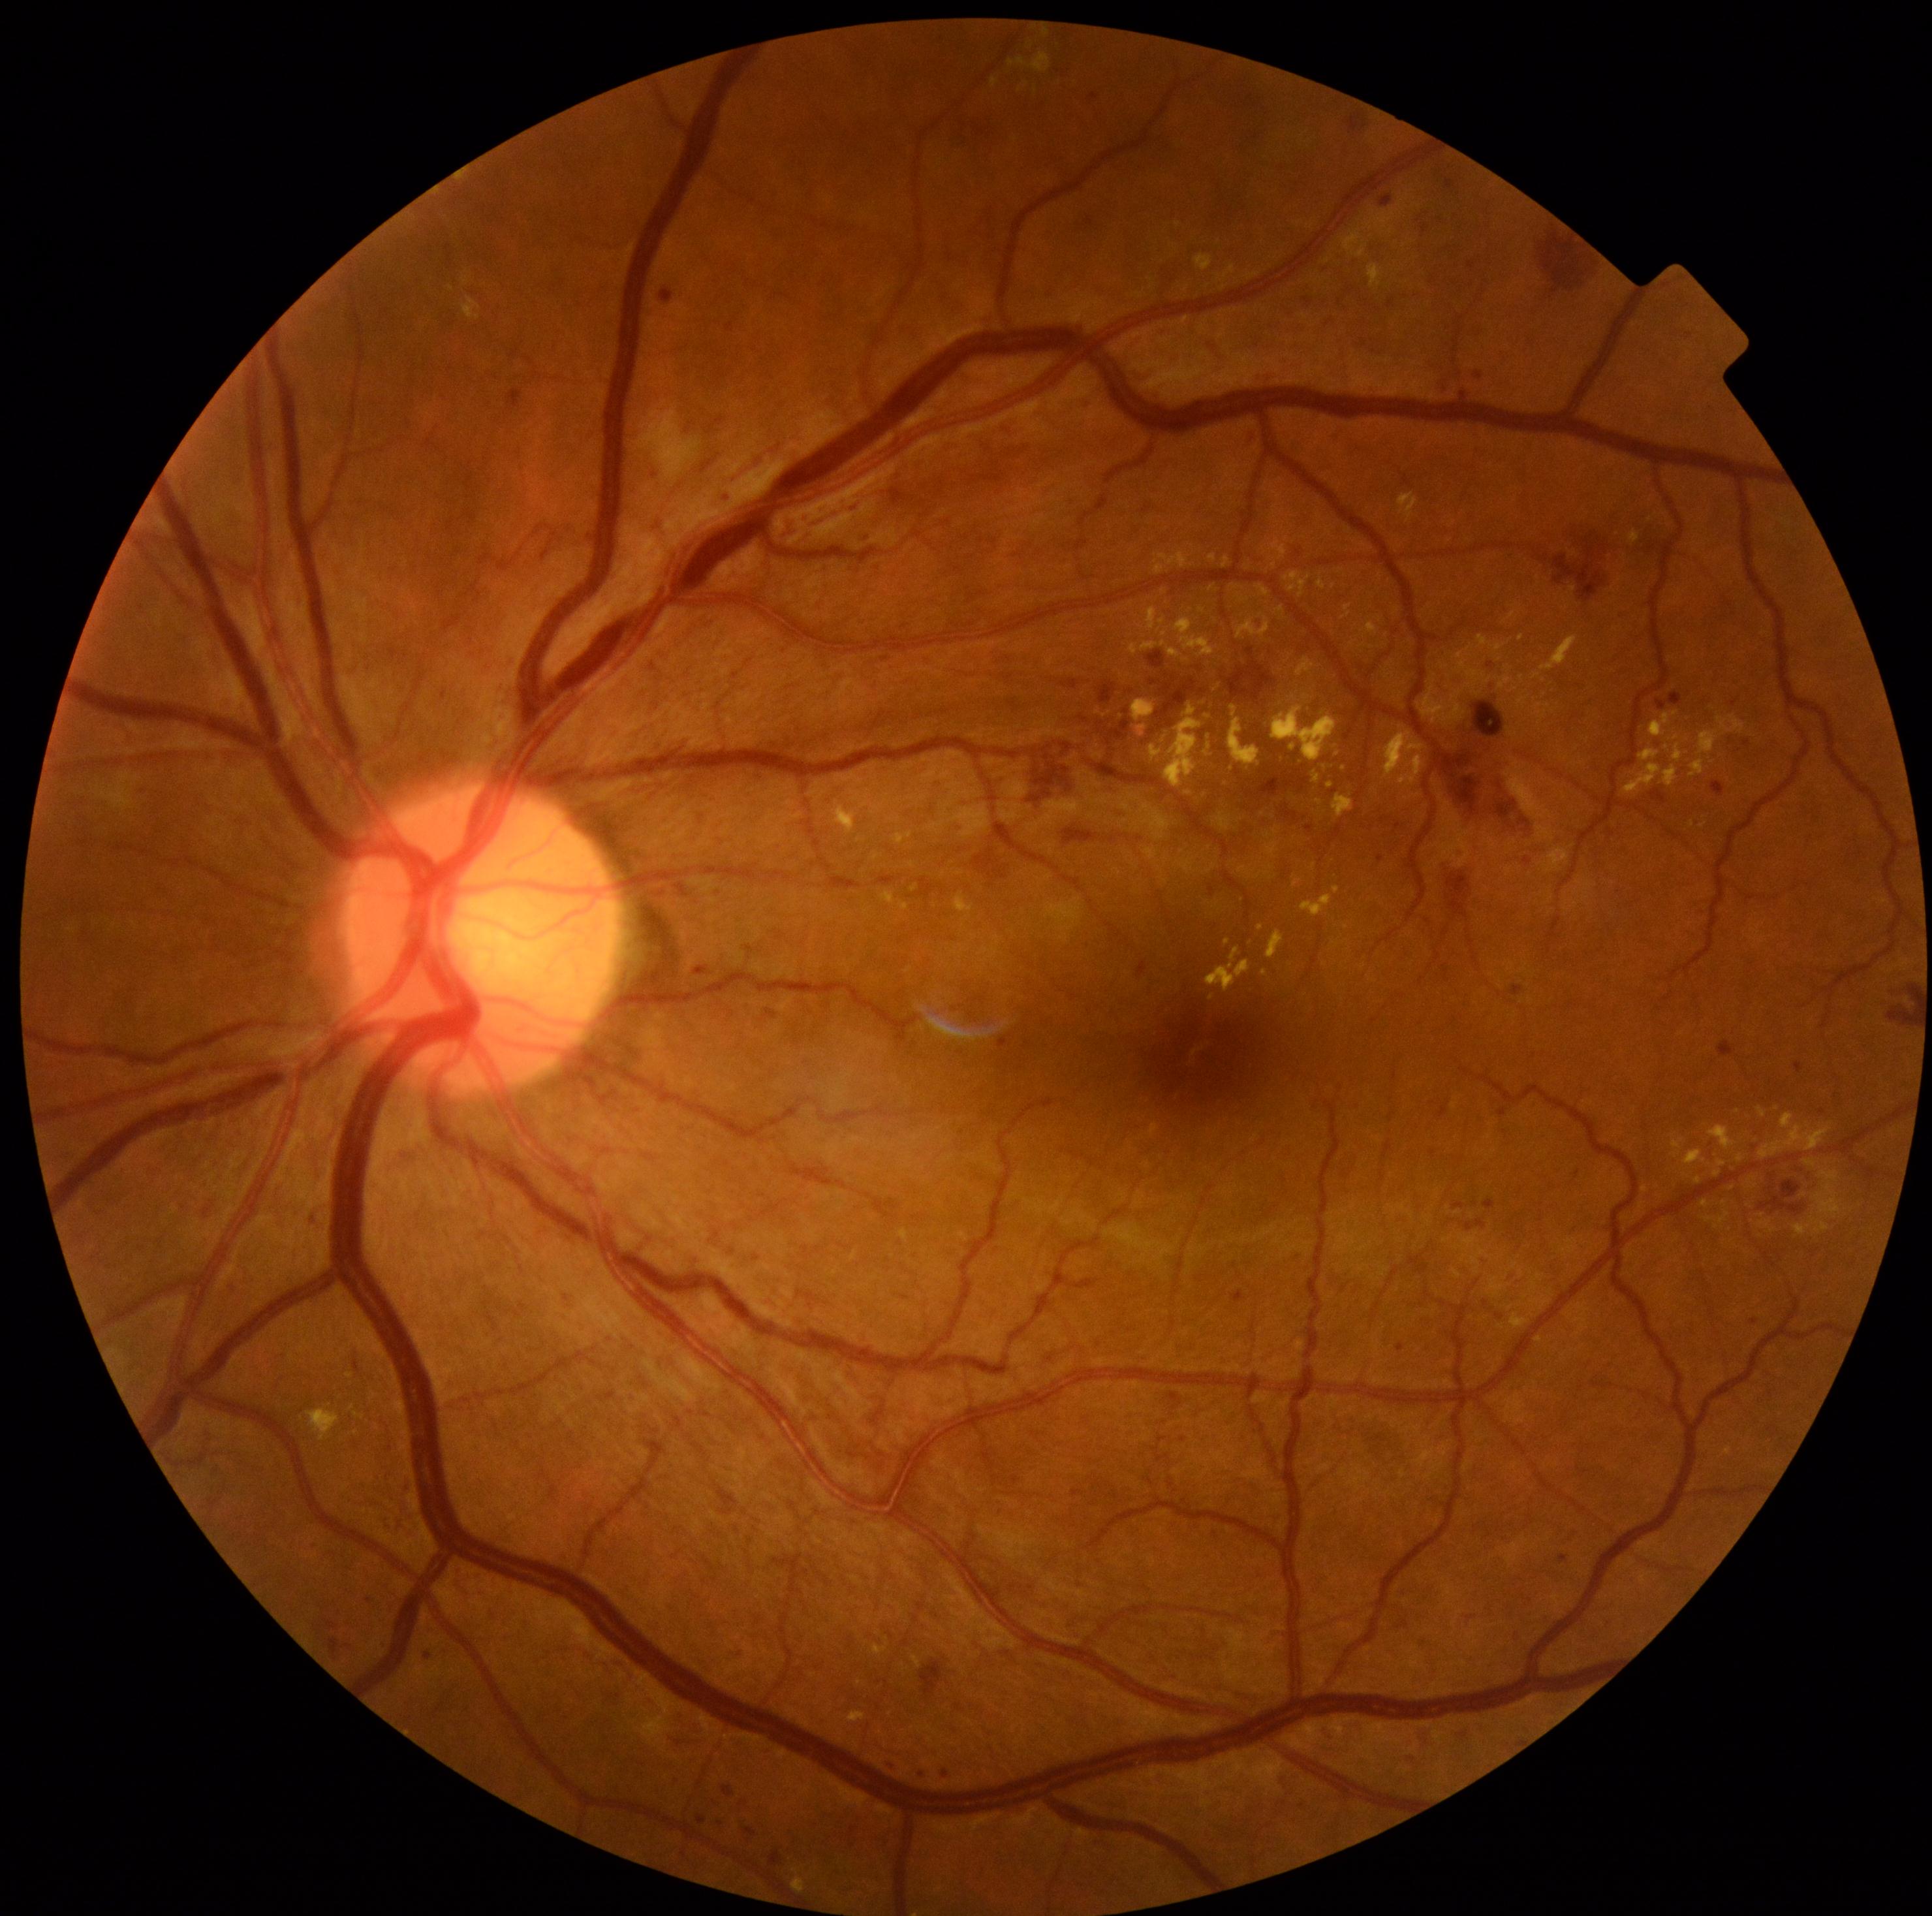
DR severity: severe NPDR (grade 3).